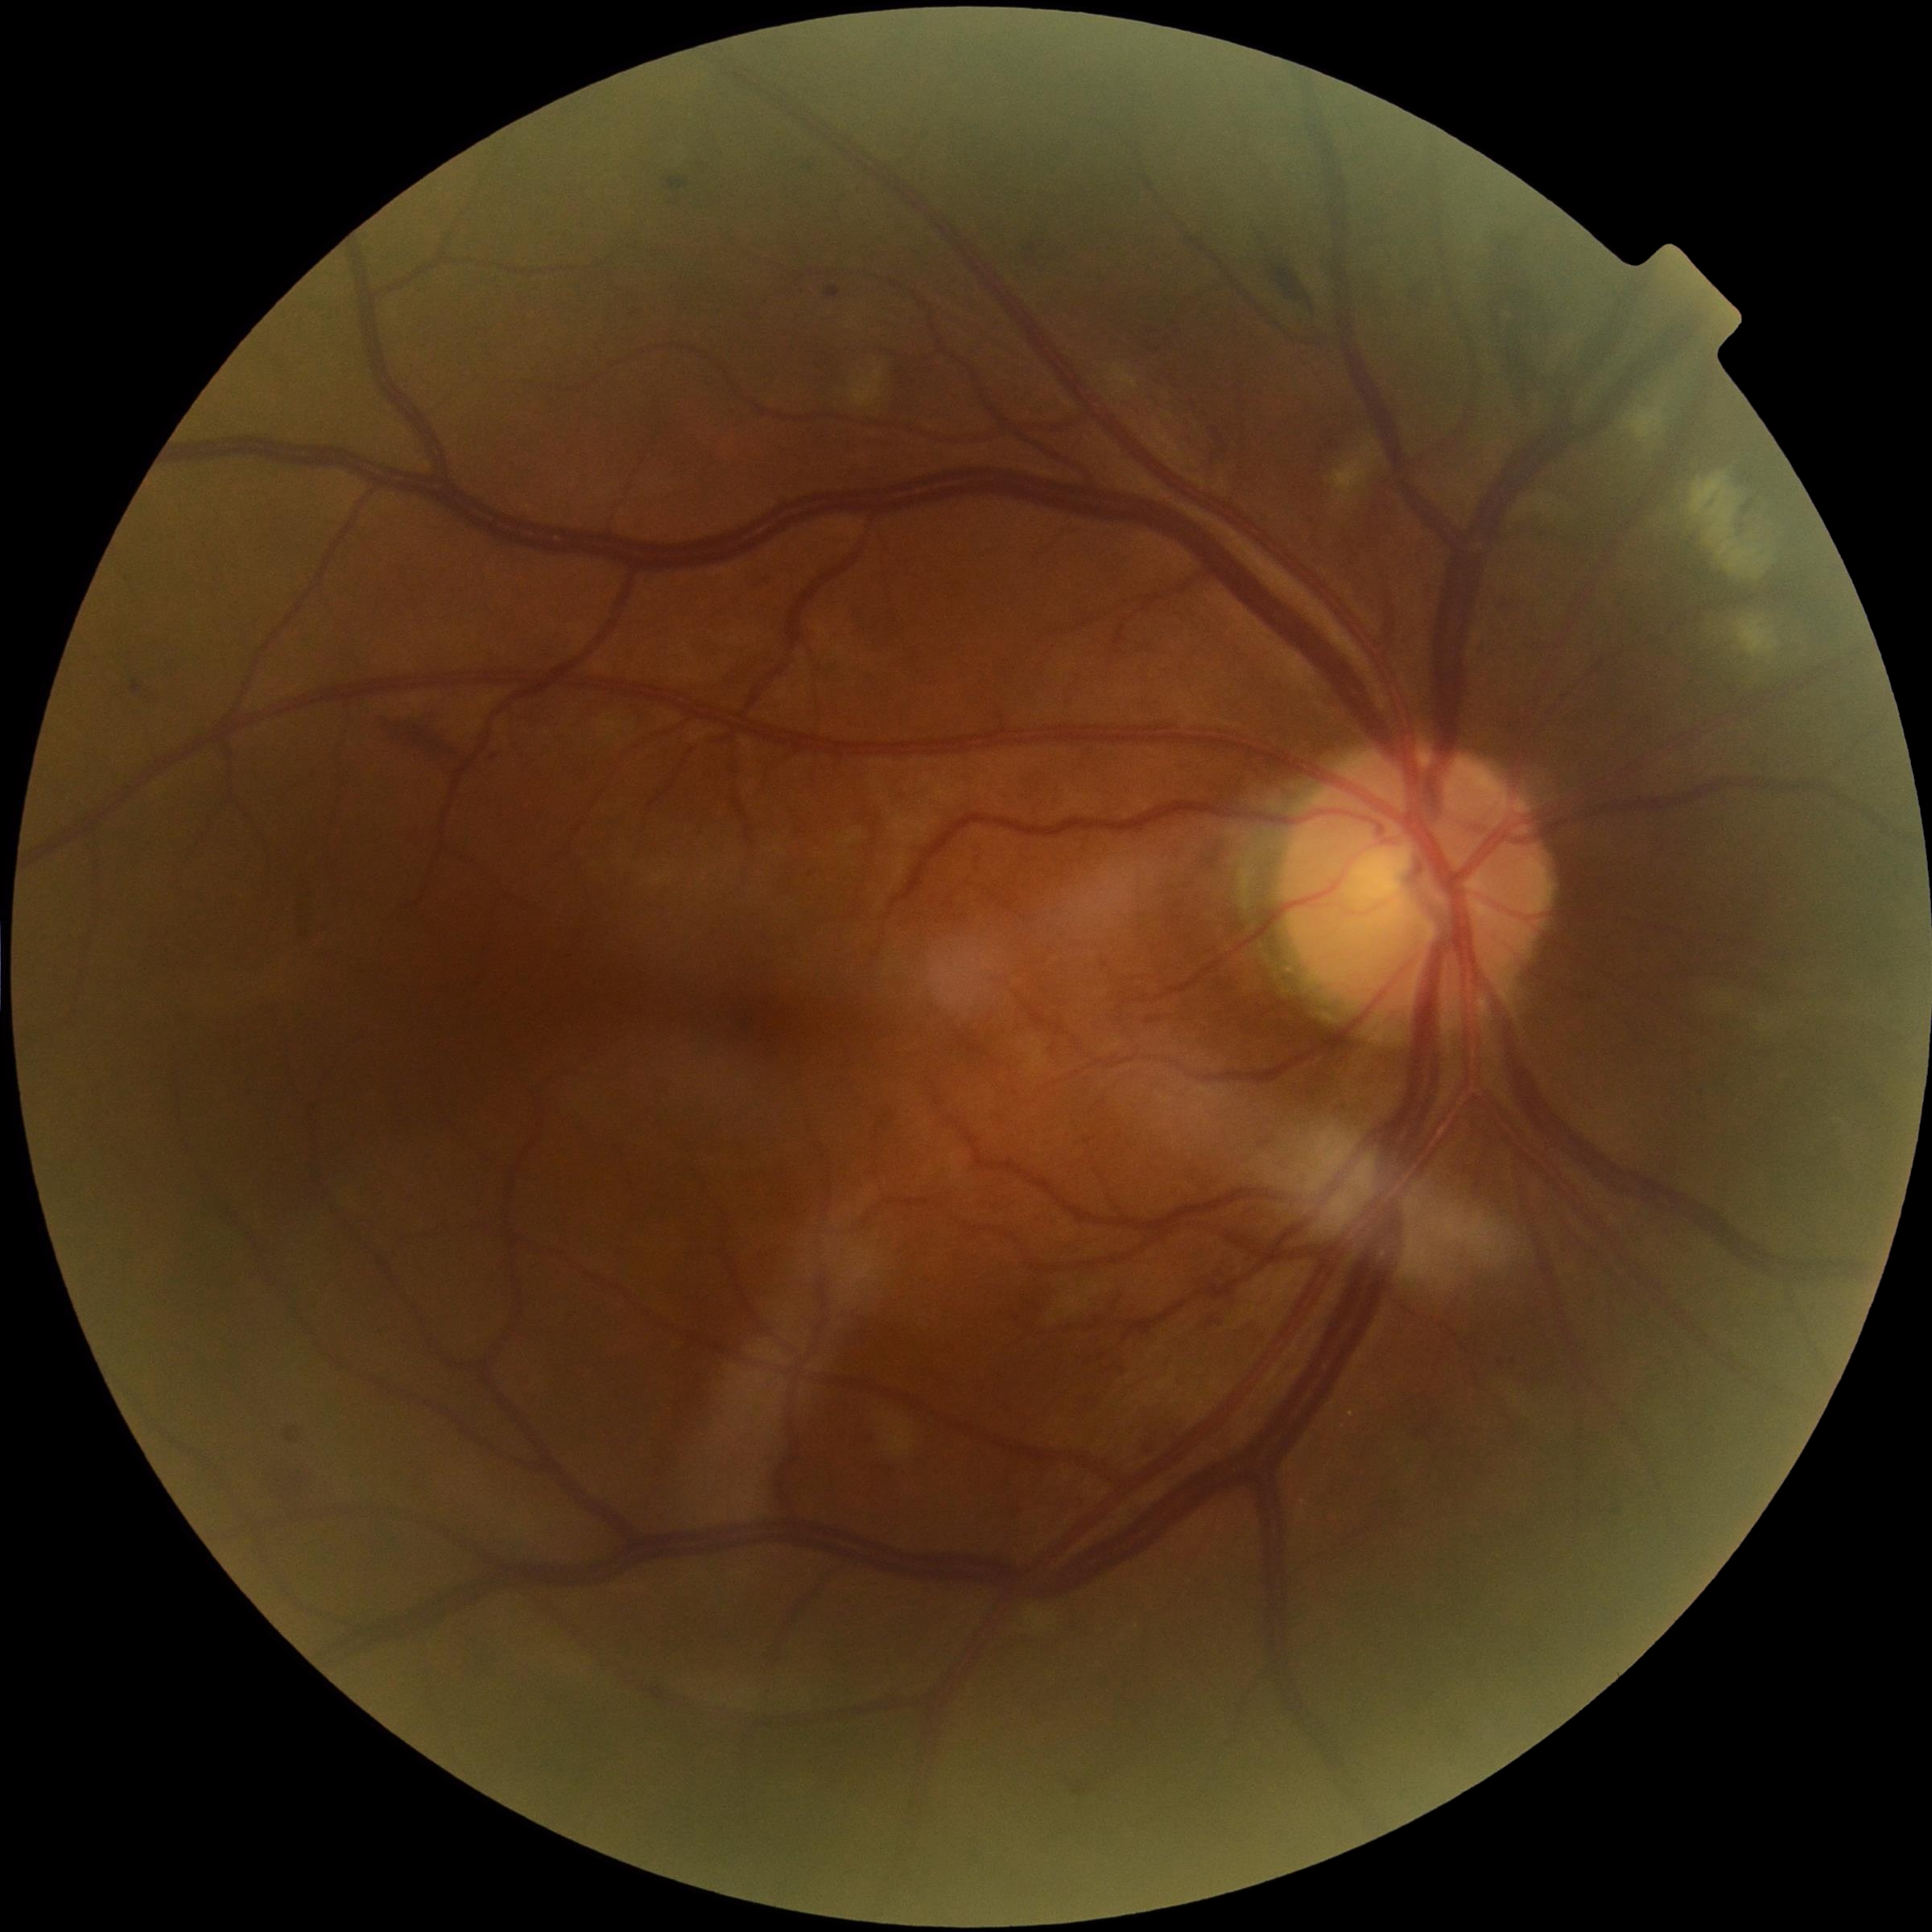

Diabetic retinopathy grade: moderate non-proliferative diabetic retinopathy (2).